Color fundus photograph; image size 2089x1764 — 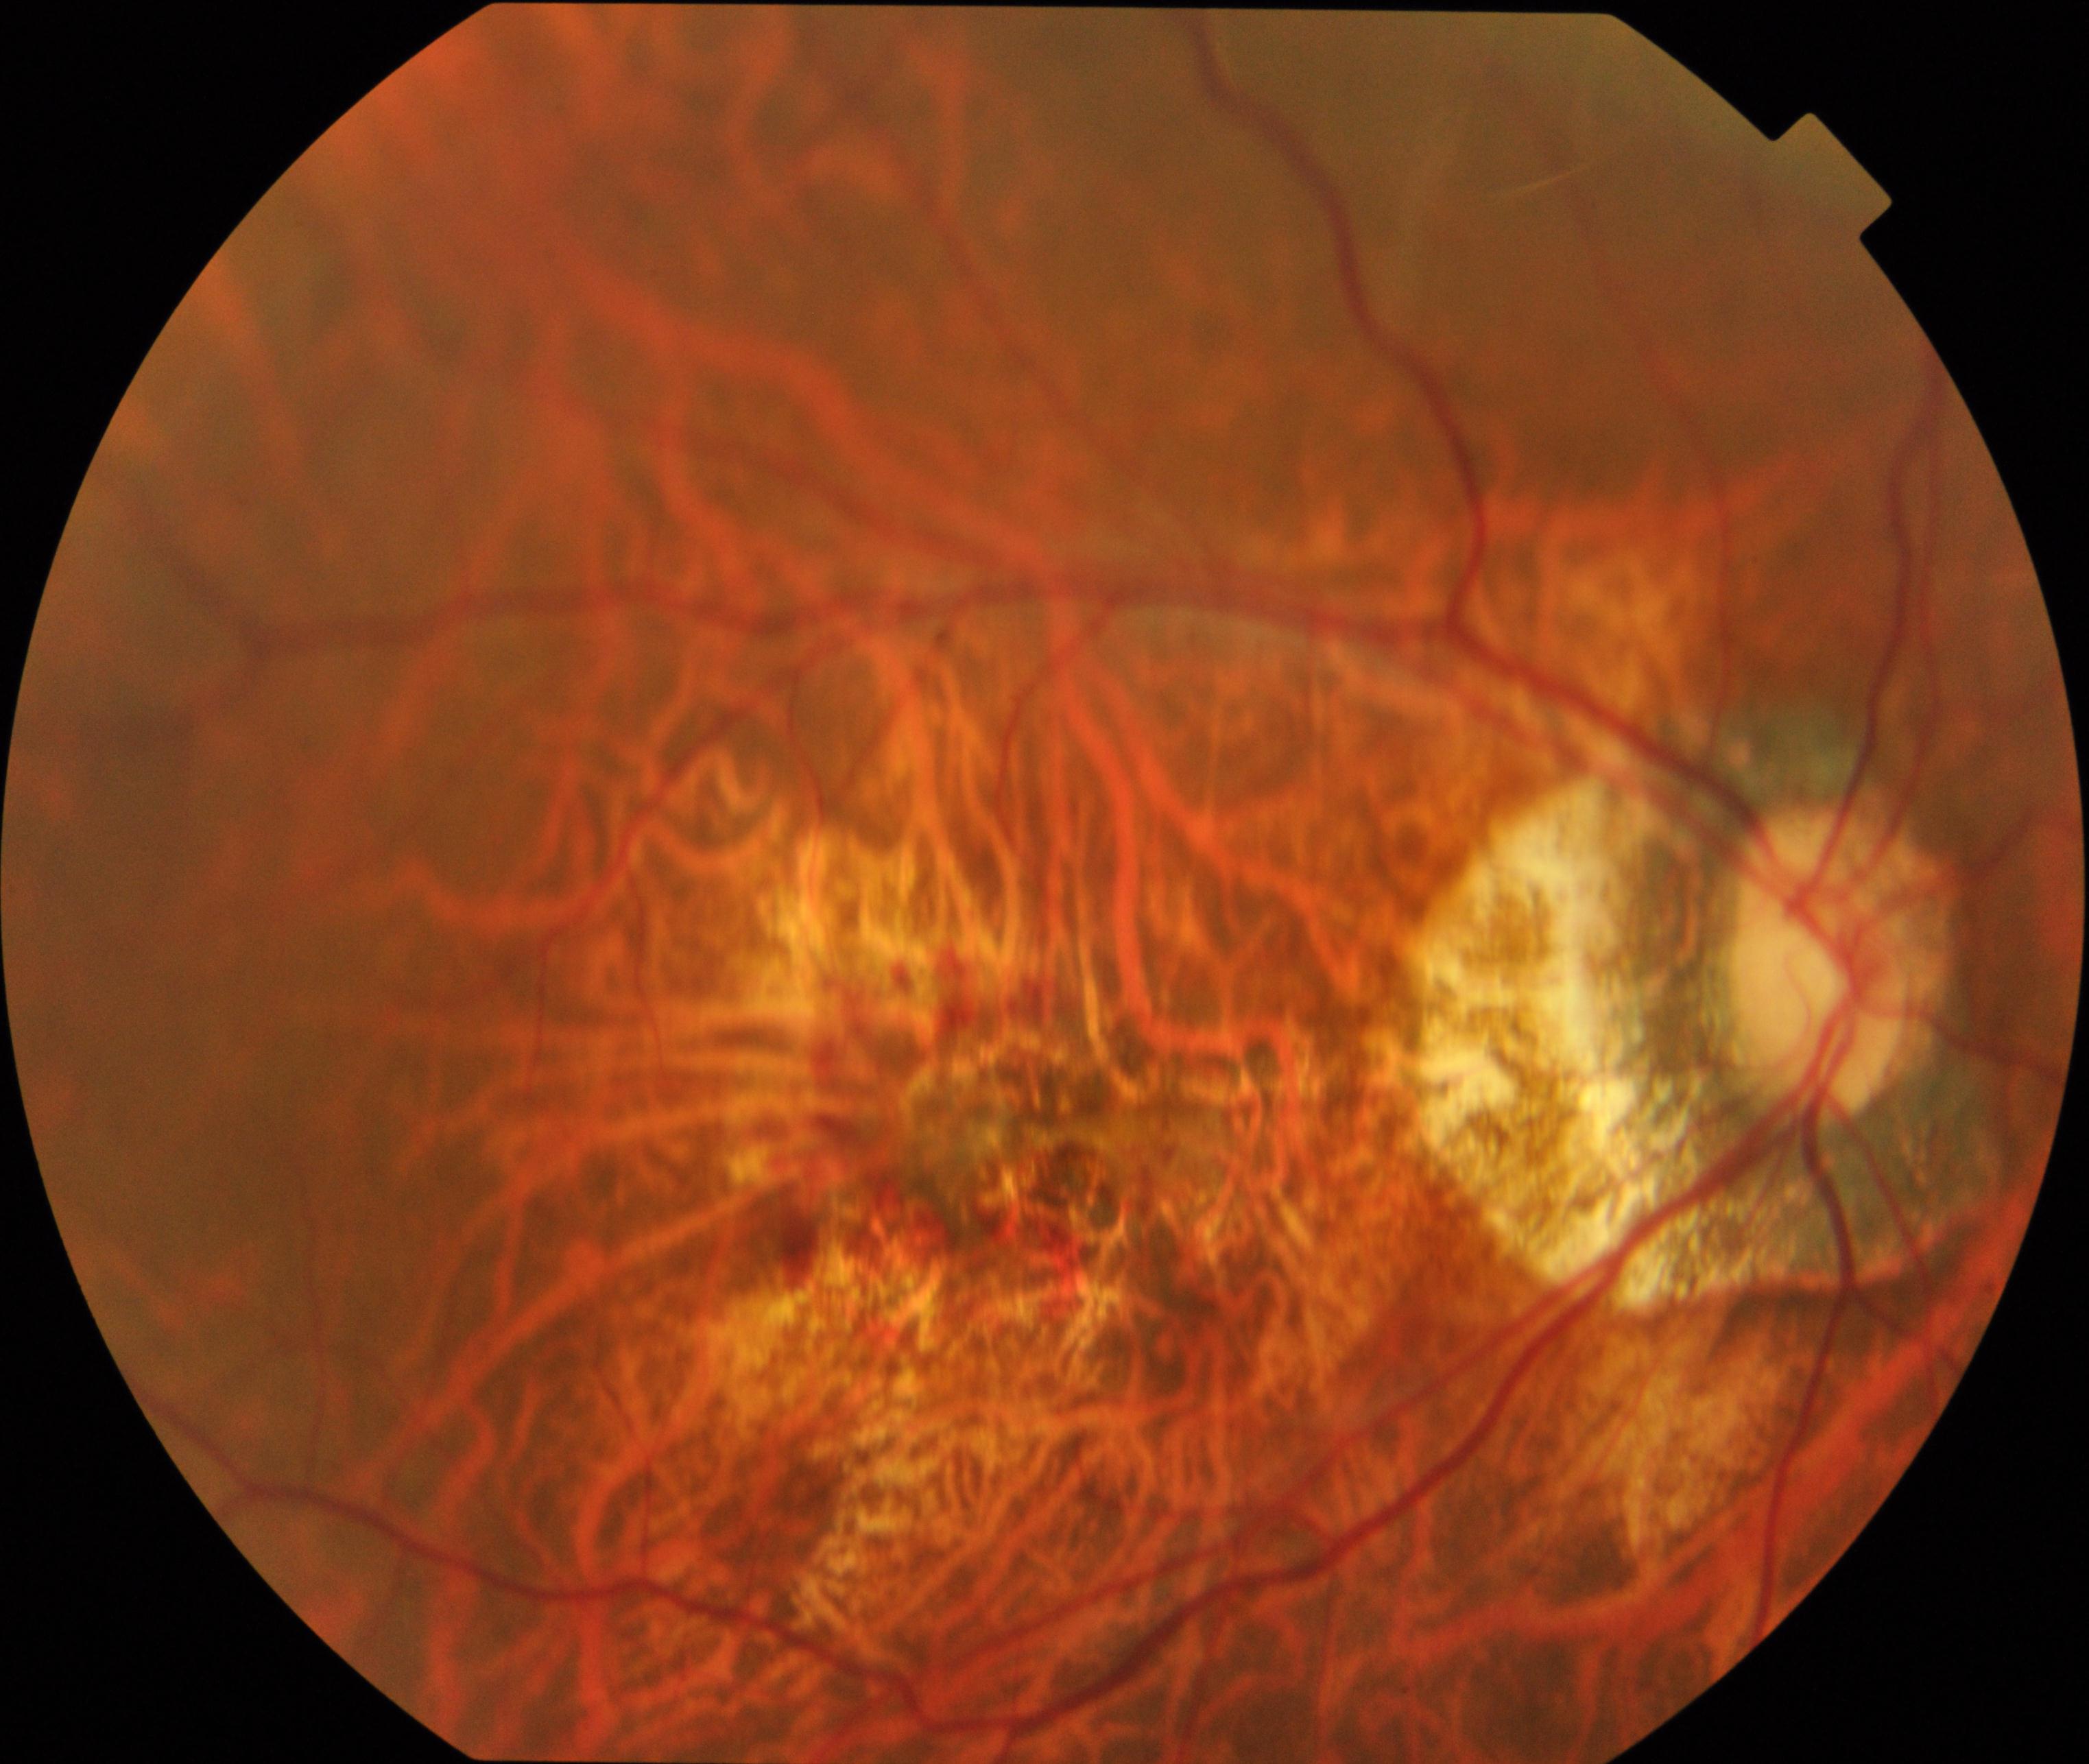
Primary finding: pathological myopia.